1240 by 1240 pixels · wide-field fundus photograph from neonatal ROP screening · 100° field of view (Phoenix ICON): 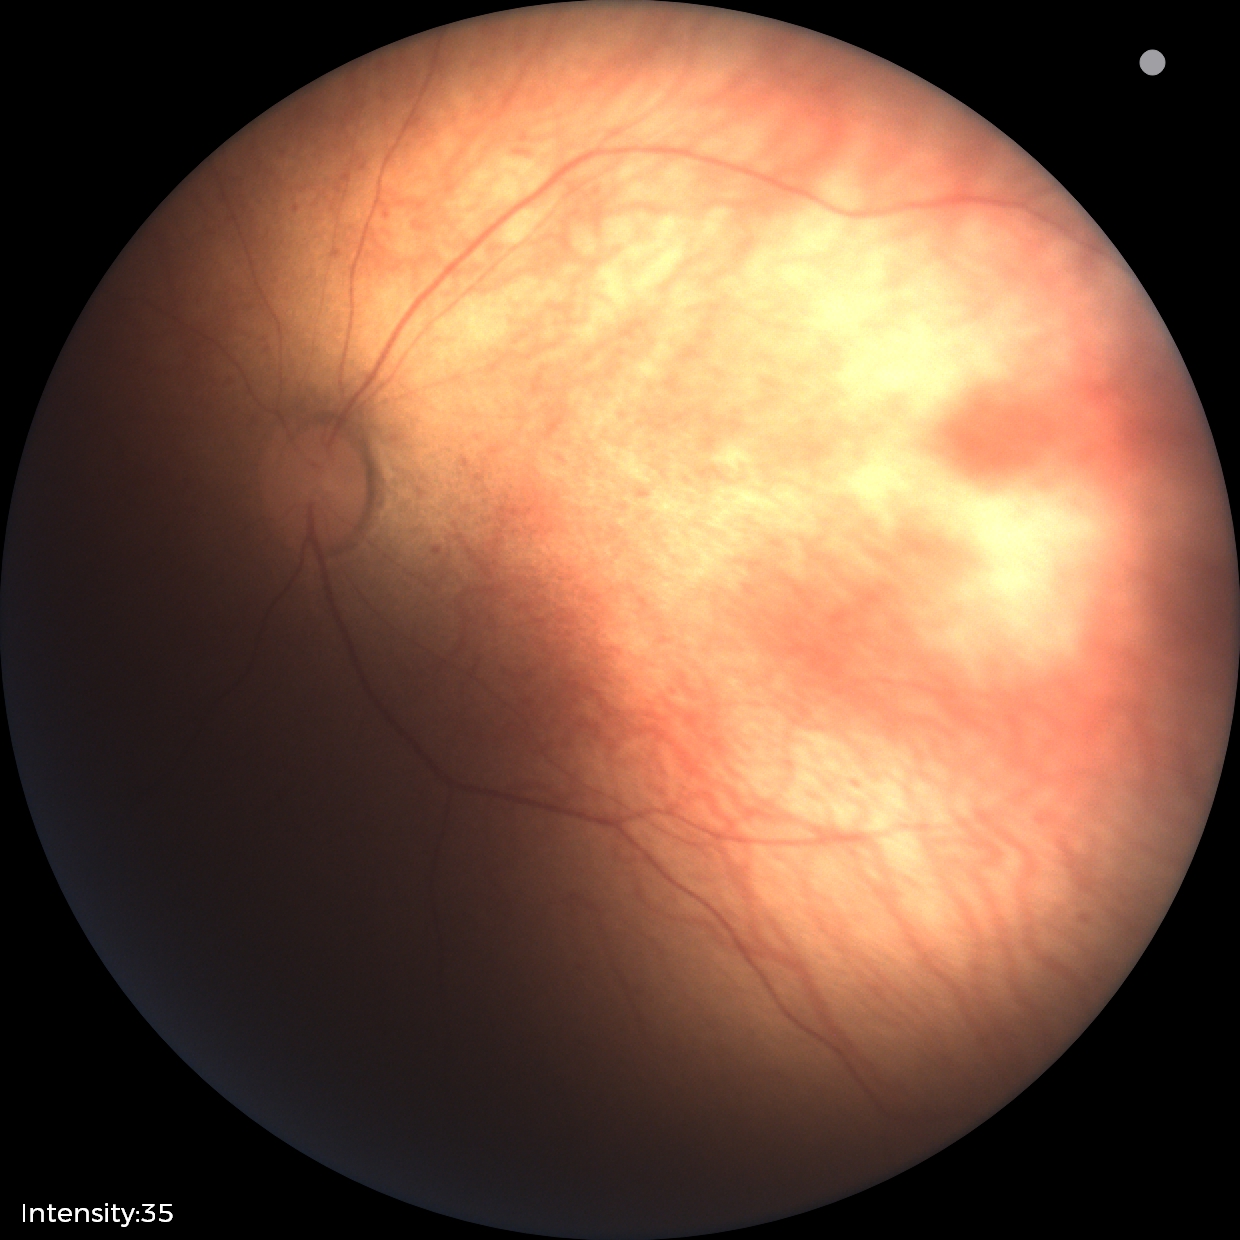 Q: Plus disease status?
A: no plus disease
Q: What is the diagnosis from this examination?
A: ROP stage 1